Topcon TRC fundus camera; fundus image cropped to the optic disc; cropped from a 35-degree field of view.
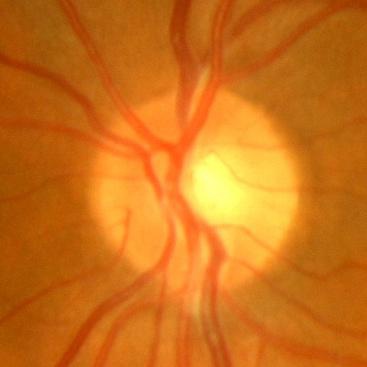 Optic disc appearance consistent with no signs of glaucoma.